2212 by 1659 pixels · CFP — 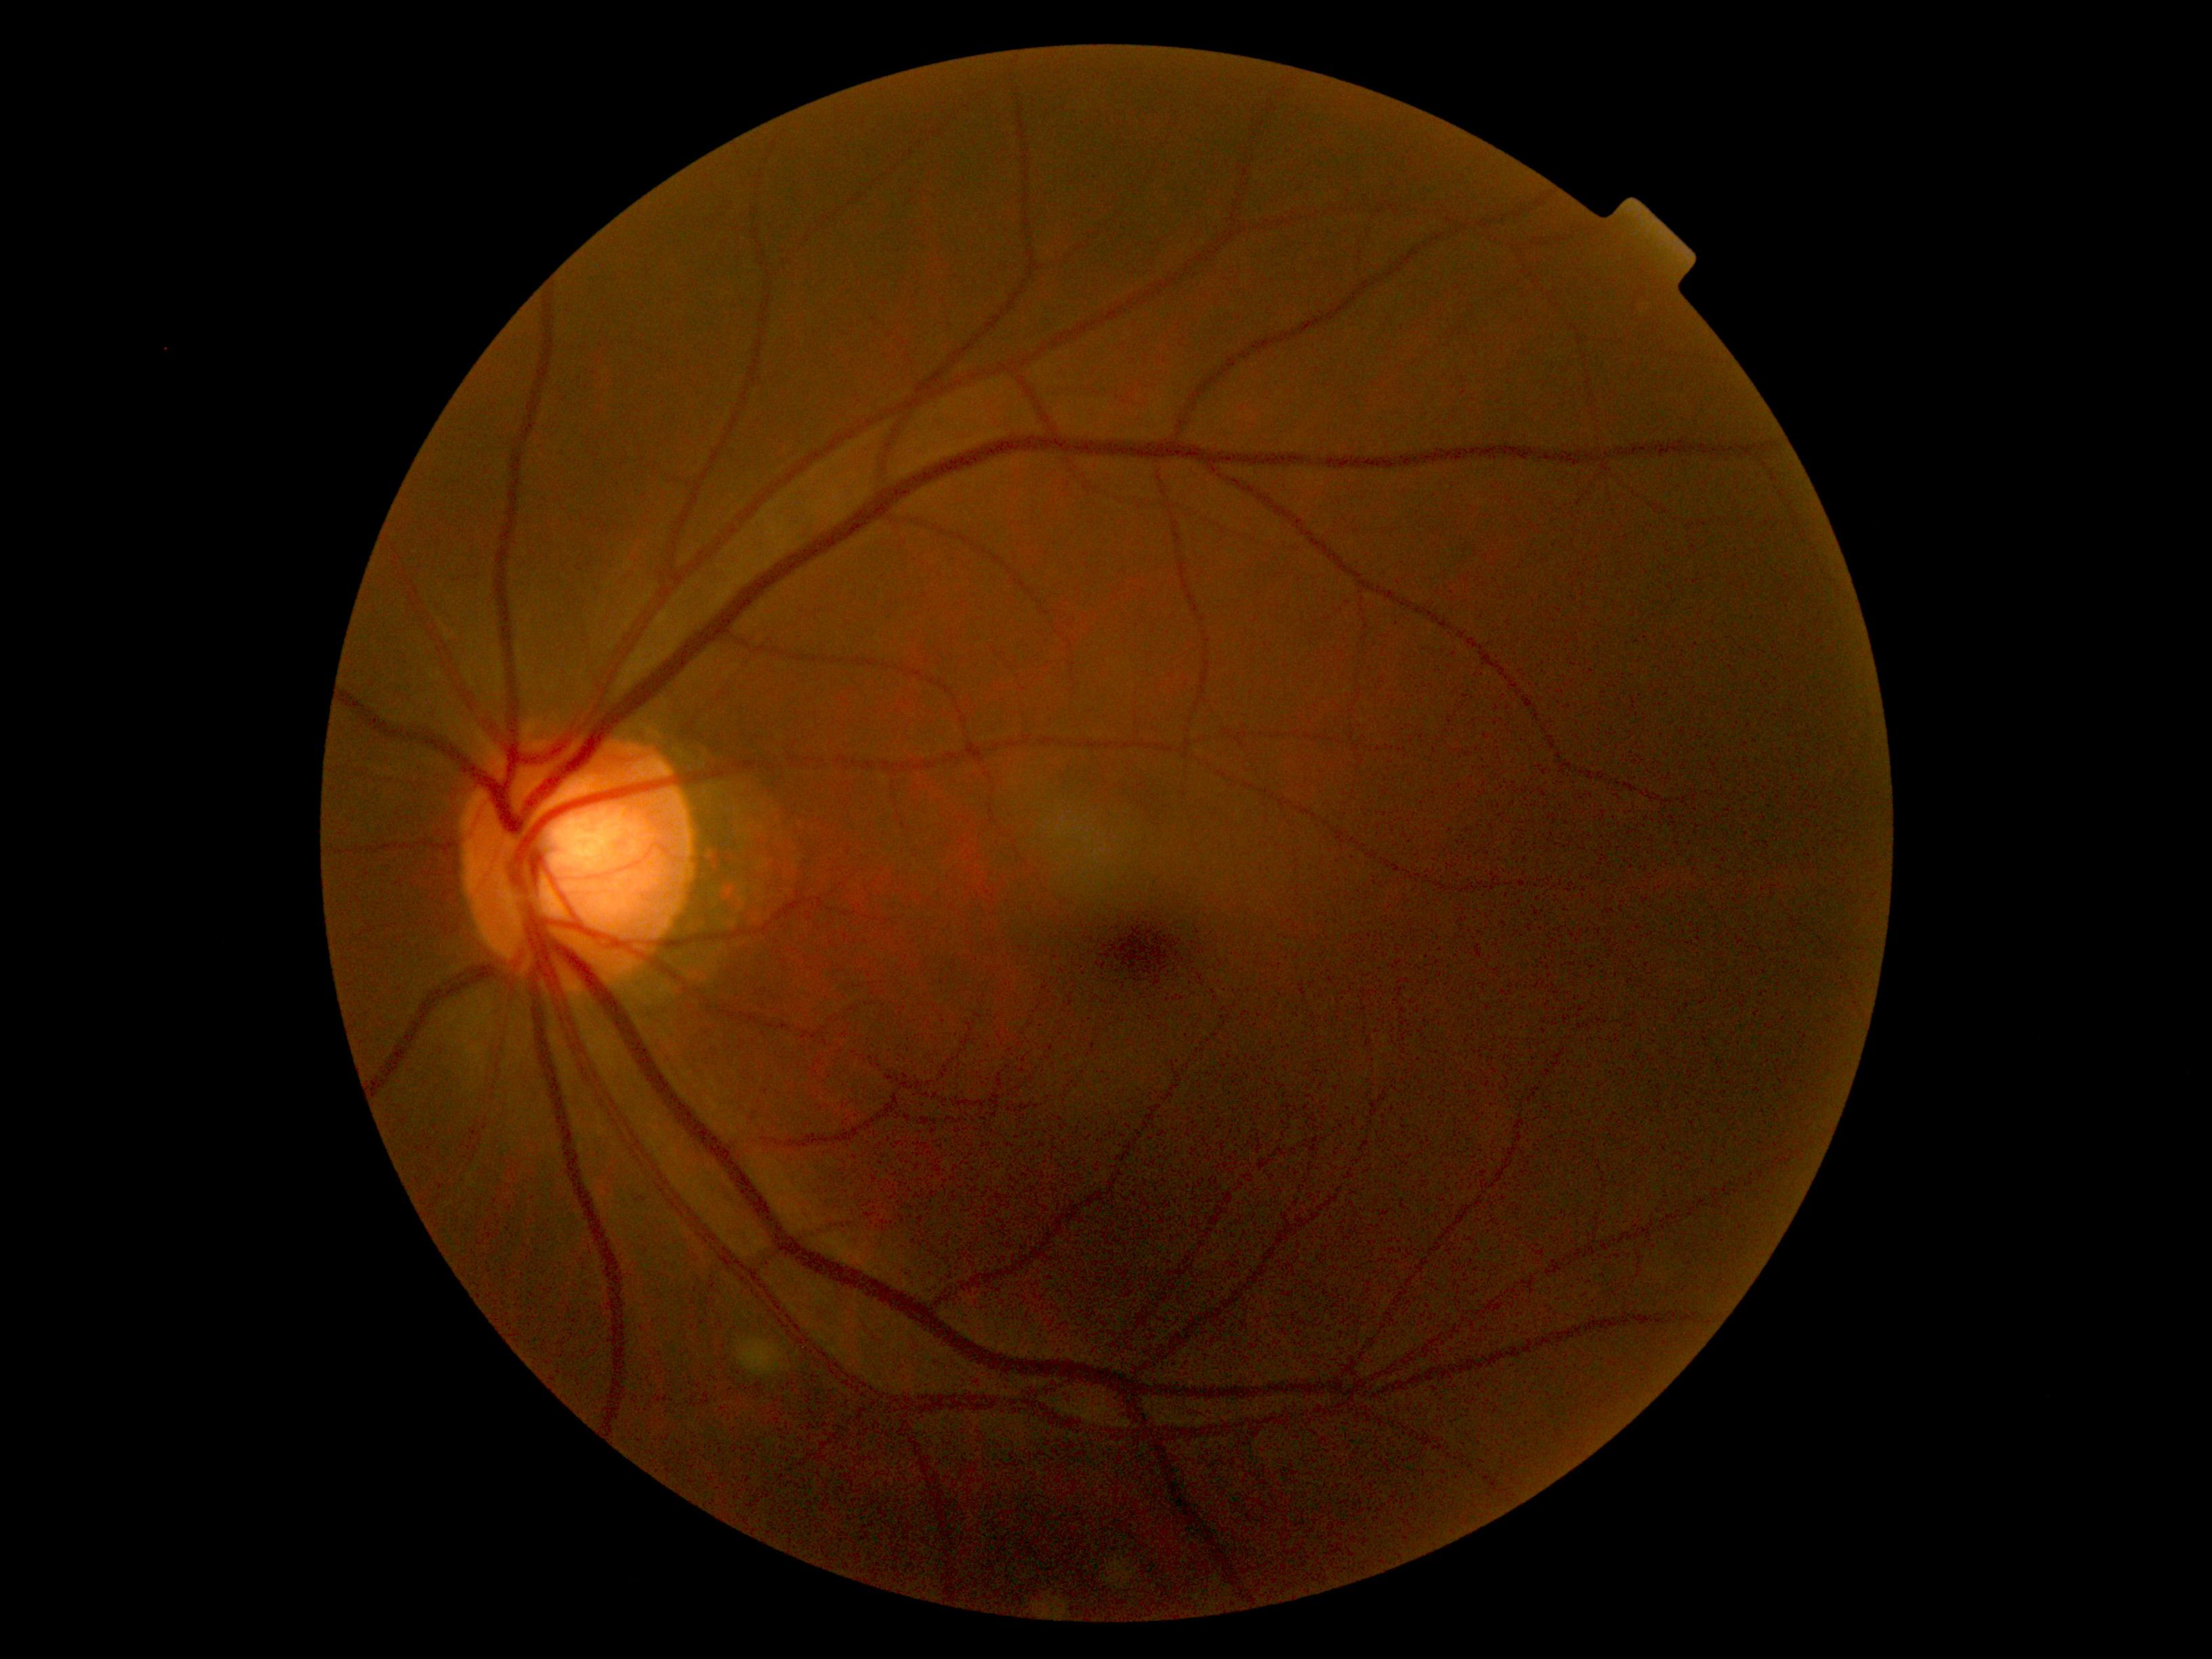 DR stage: grade 0. No DR findings.